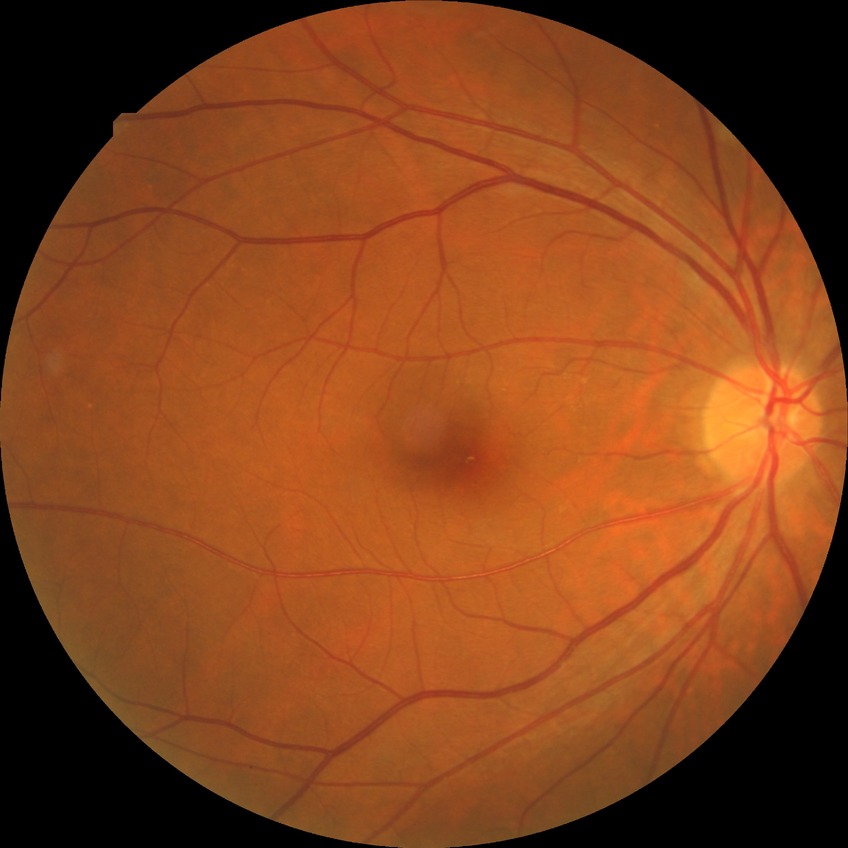
Modified Davis classification is no diabetic retinopathy.